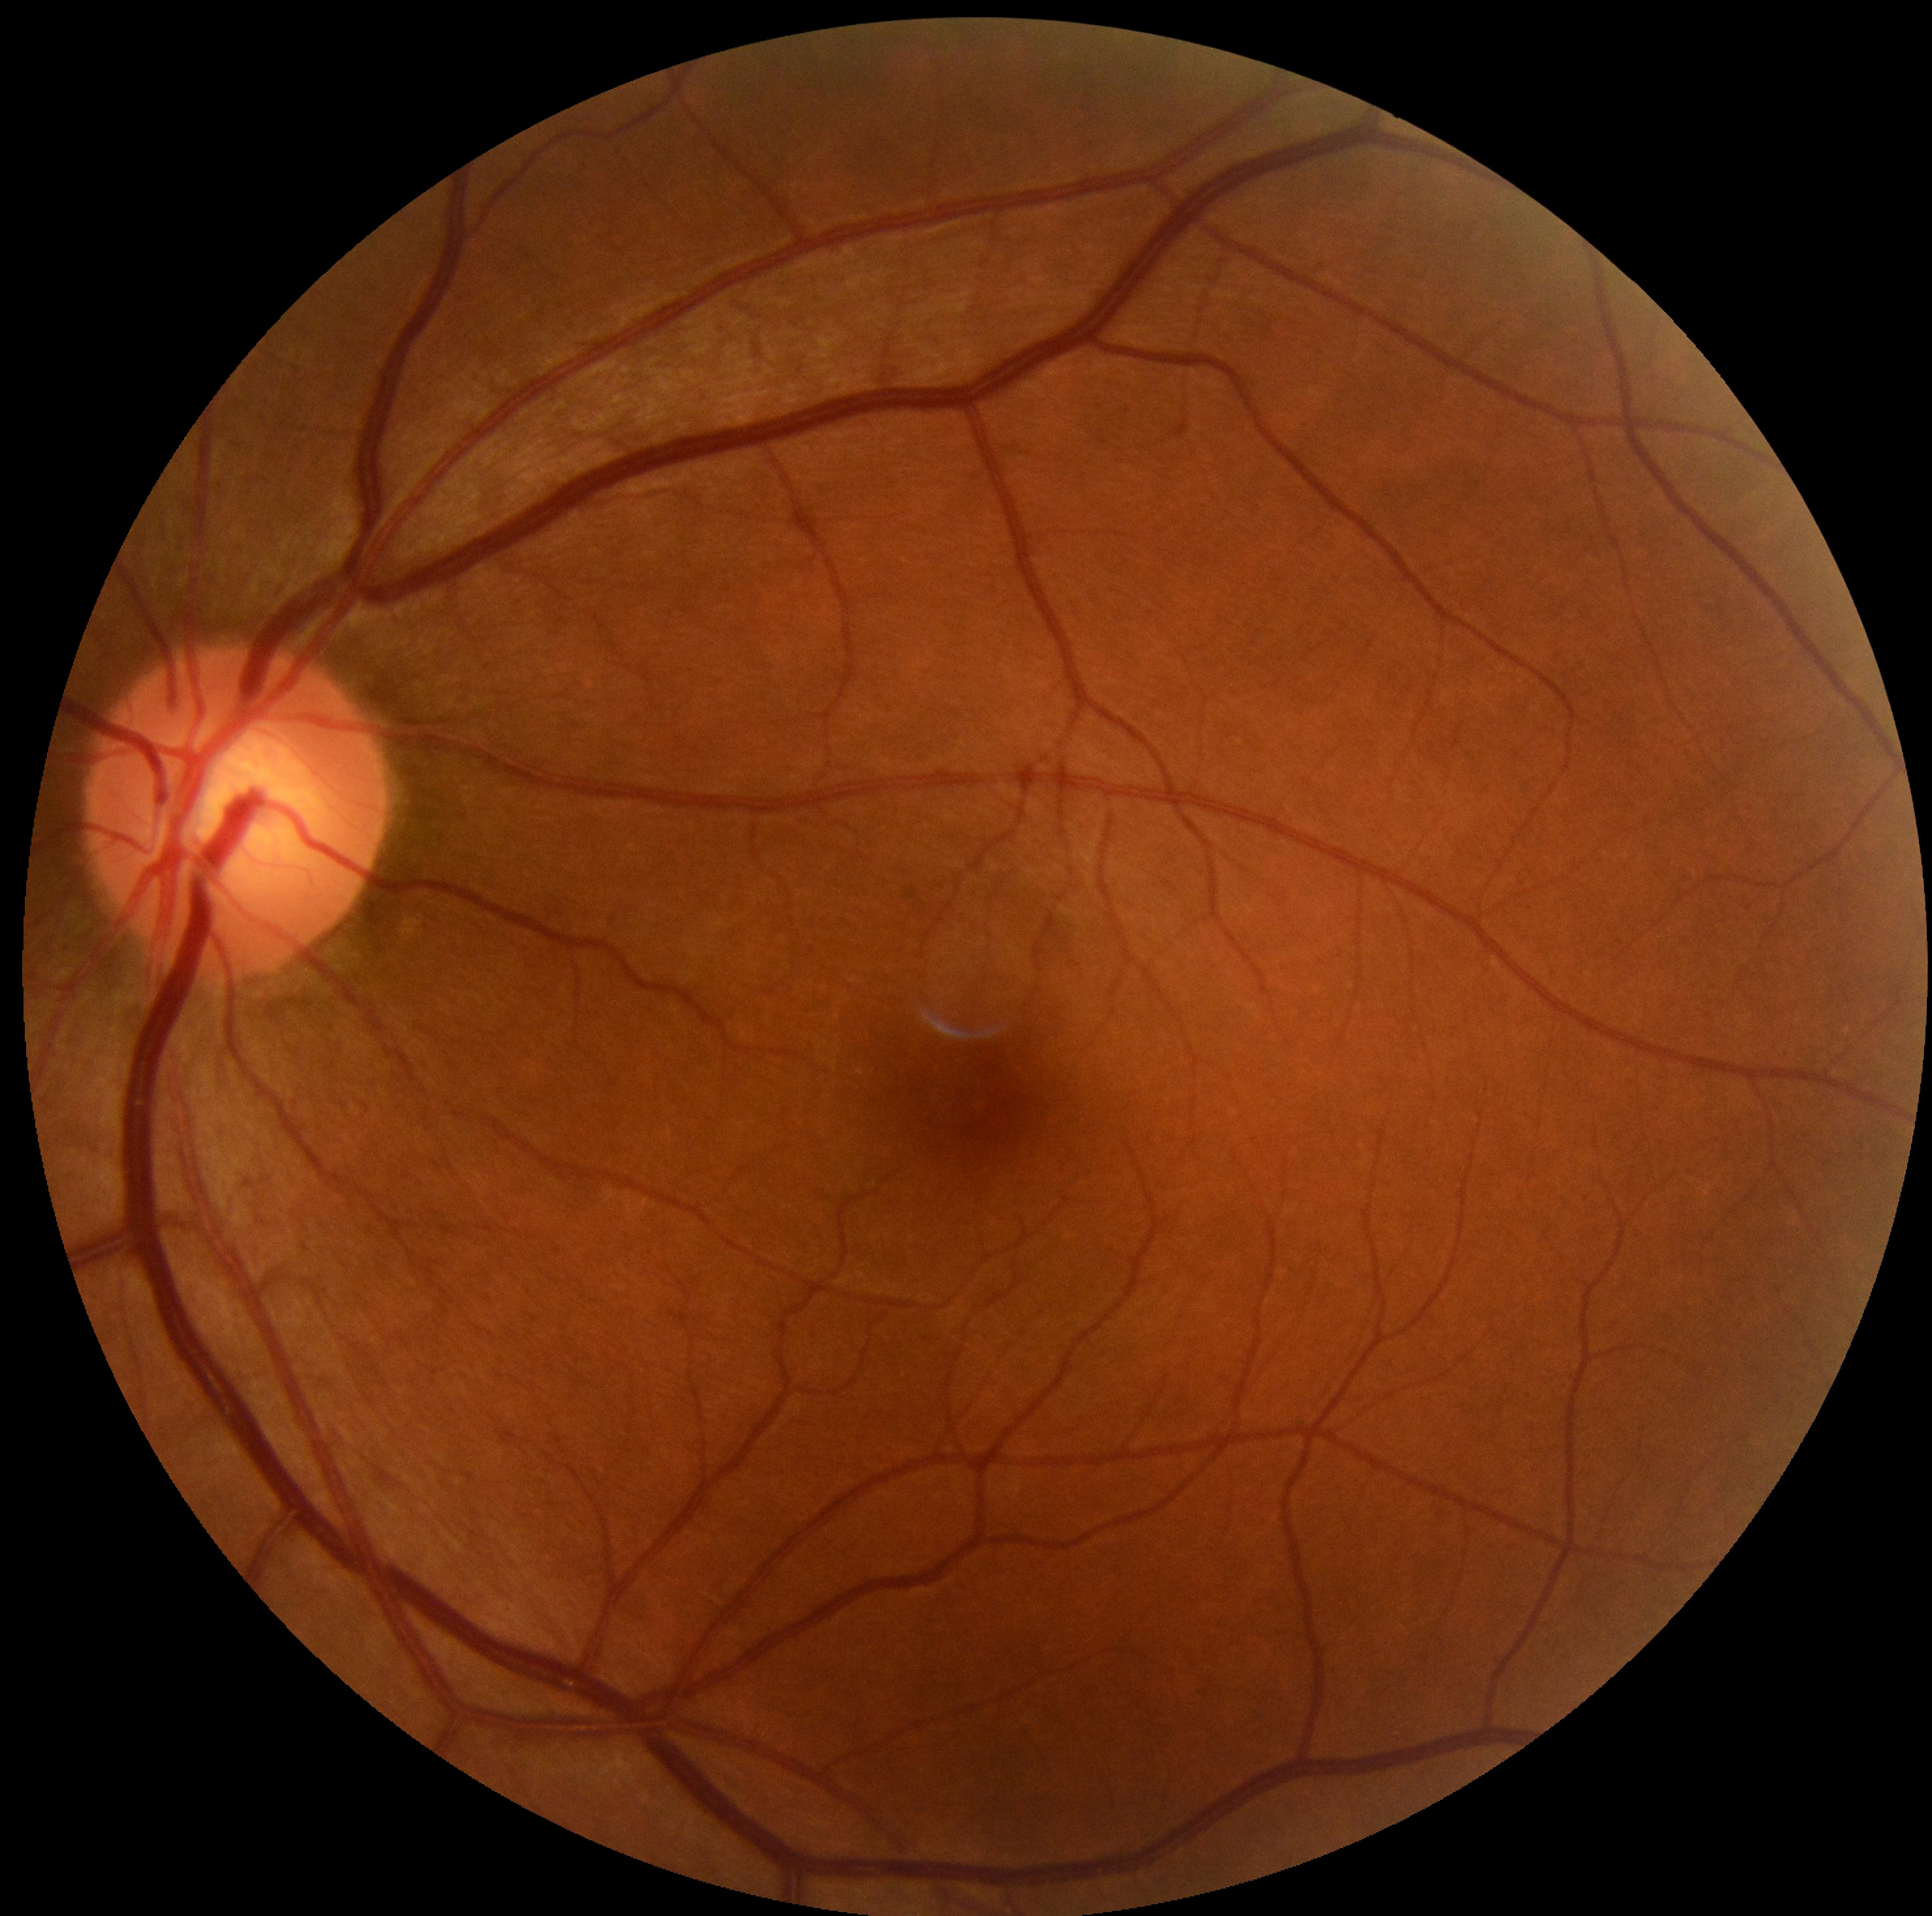
DR impression: no apparent DR, retinopathy: no apparent diabetic retinopathy (grade 0).